Nonmydriatic fundus photograph, 848 by 848 pixels — 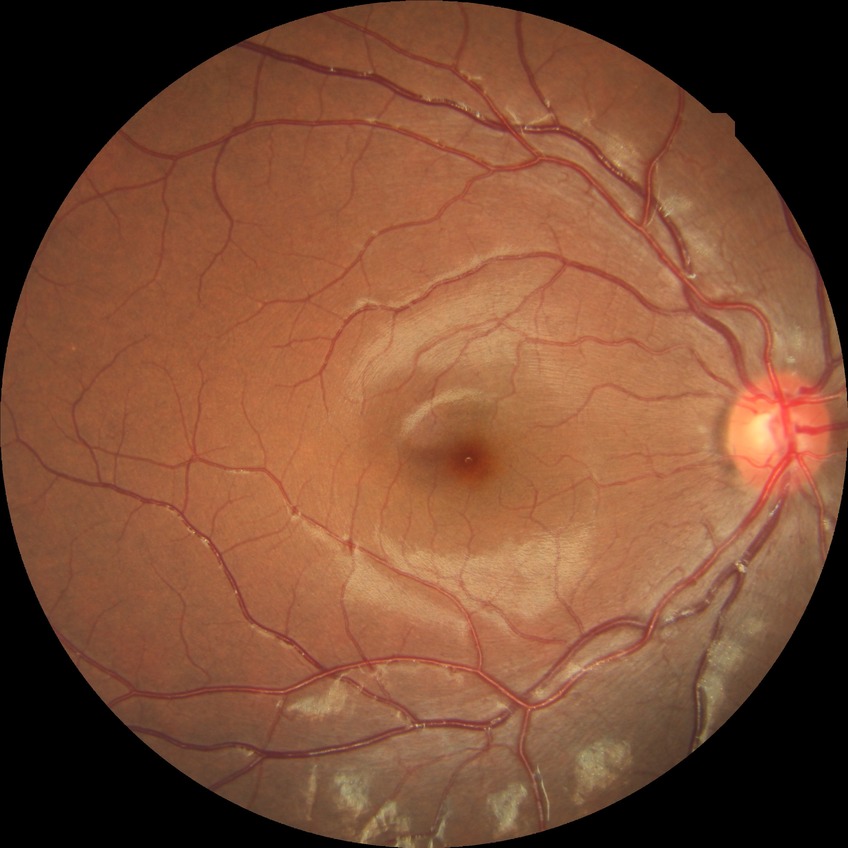

{
  "davis_grade": "simple diabetic retinopathy (SDR)"
}